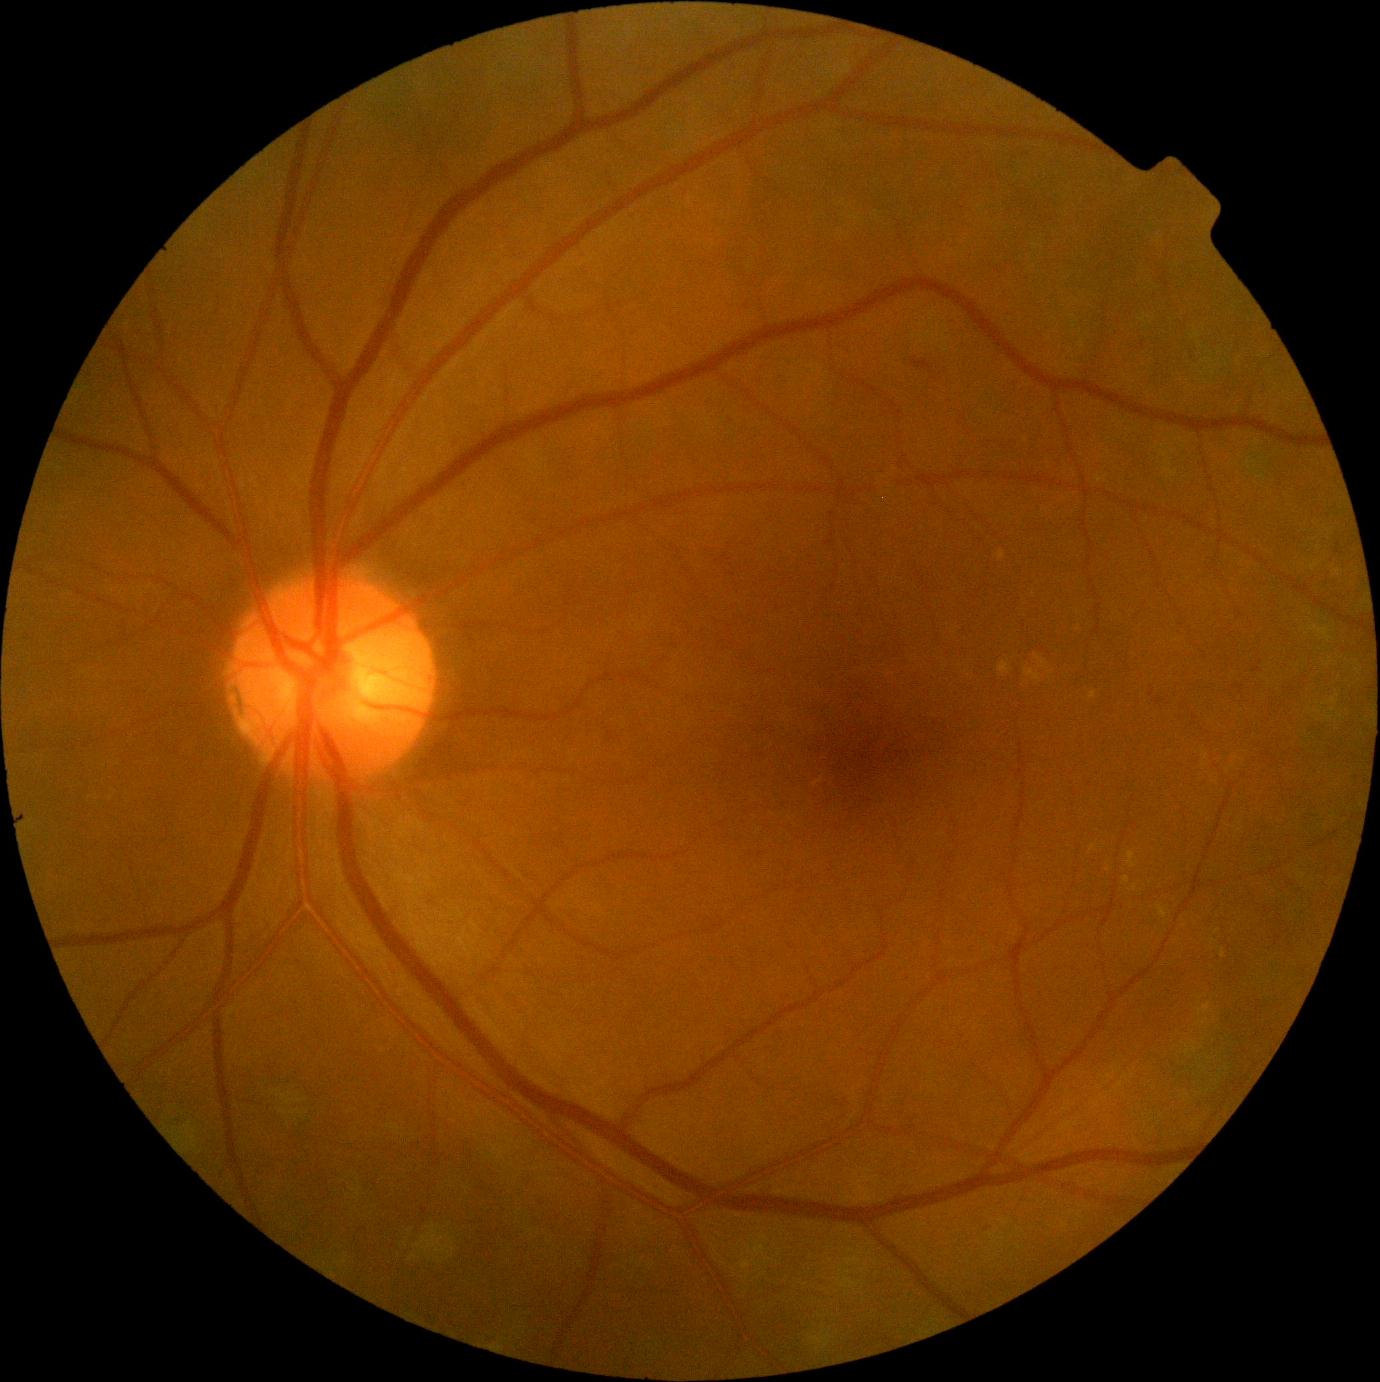 {"dr_grade": "grade 2"}